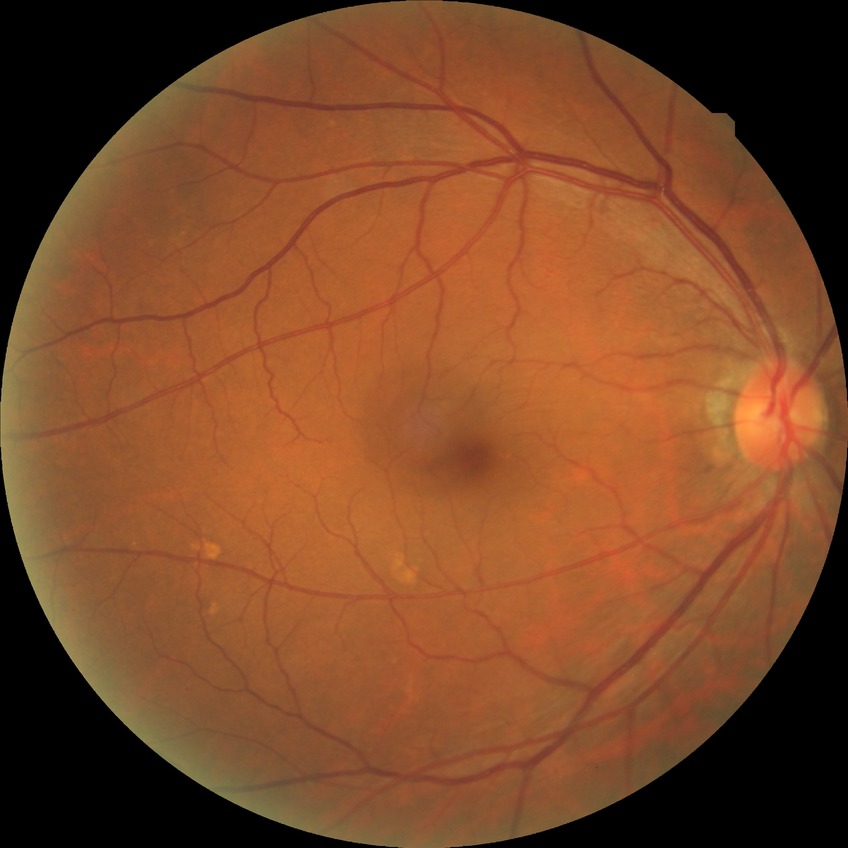

Diabetic retinopathy severity is no diabetic retinopathy.